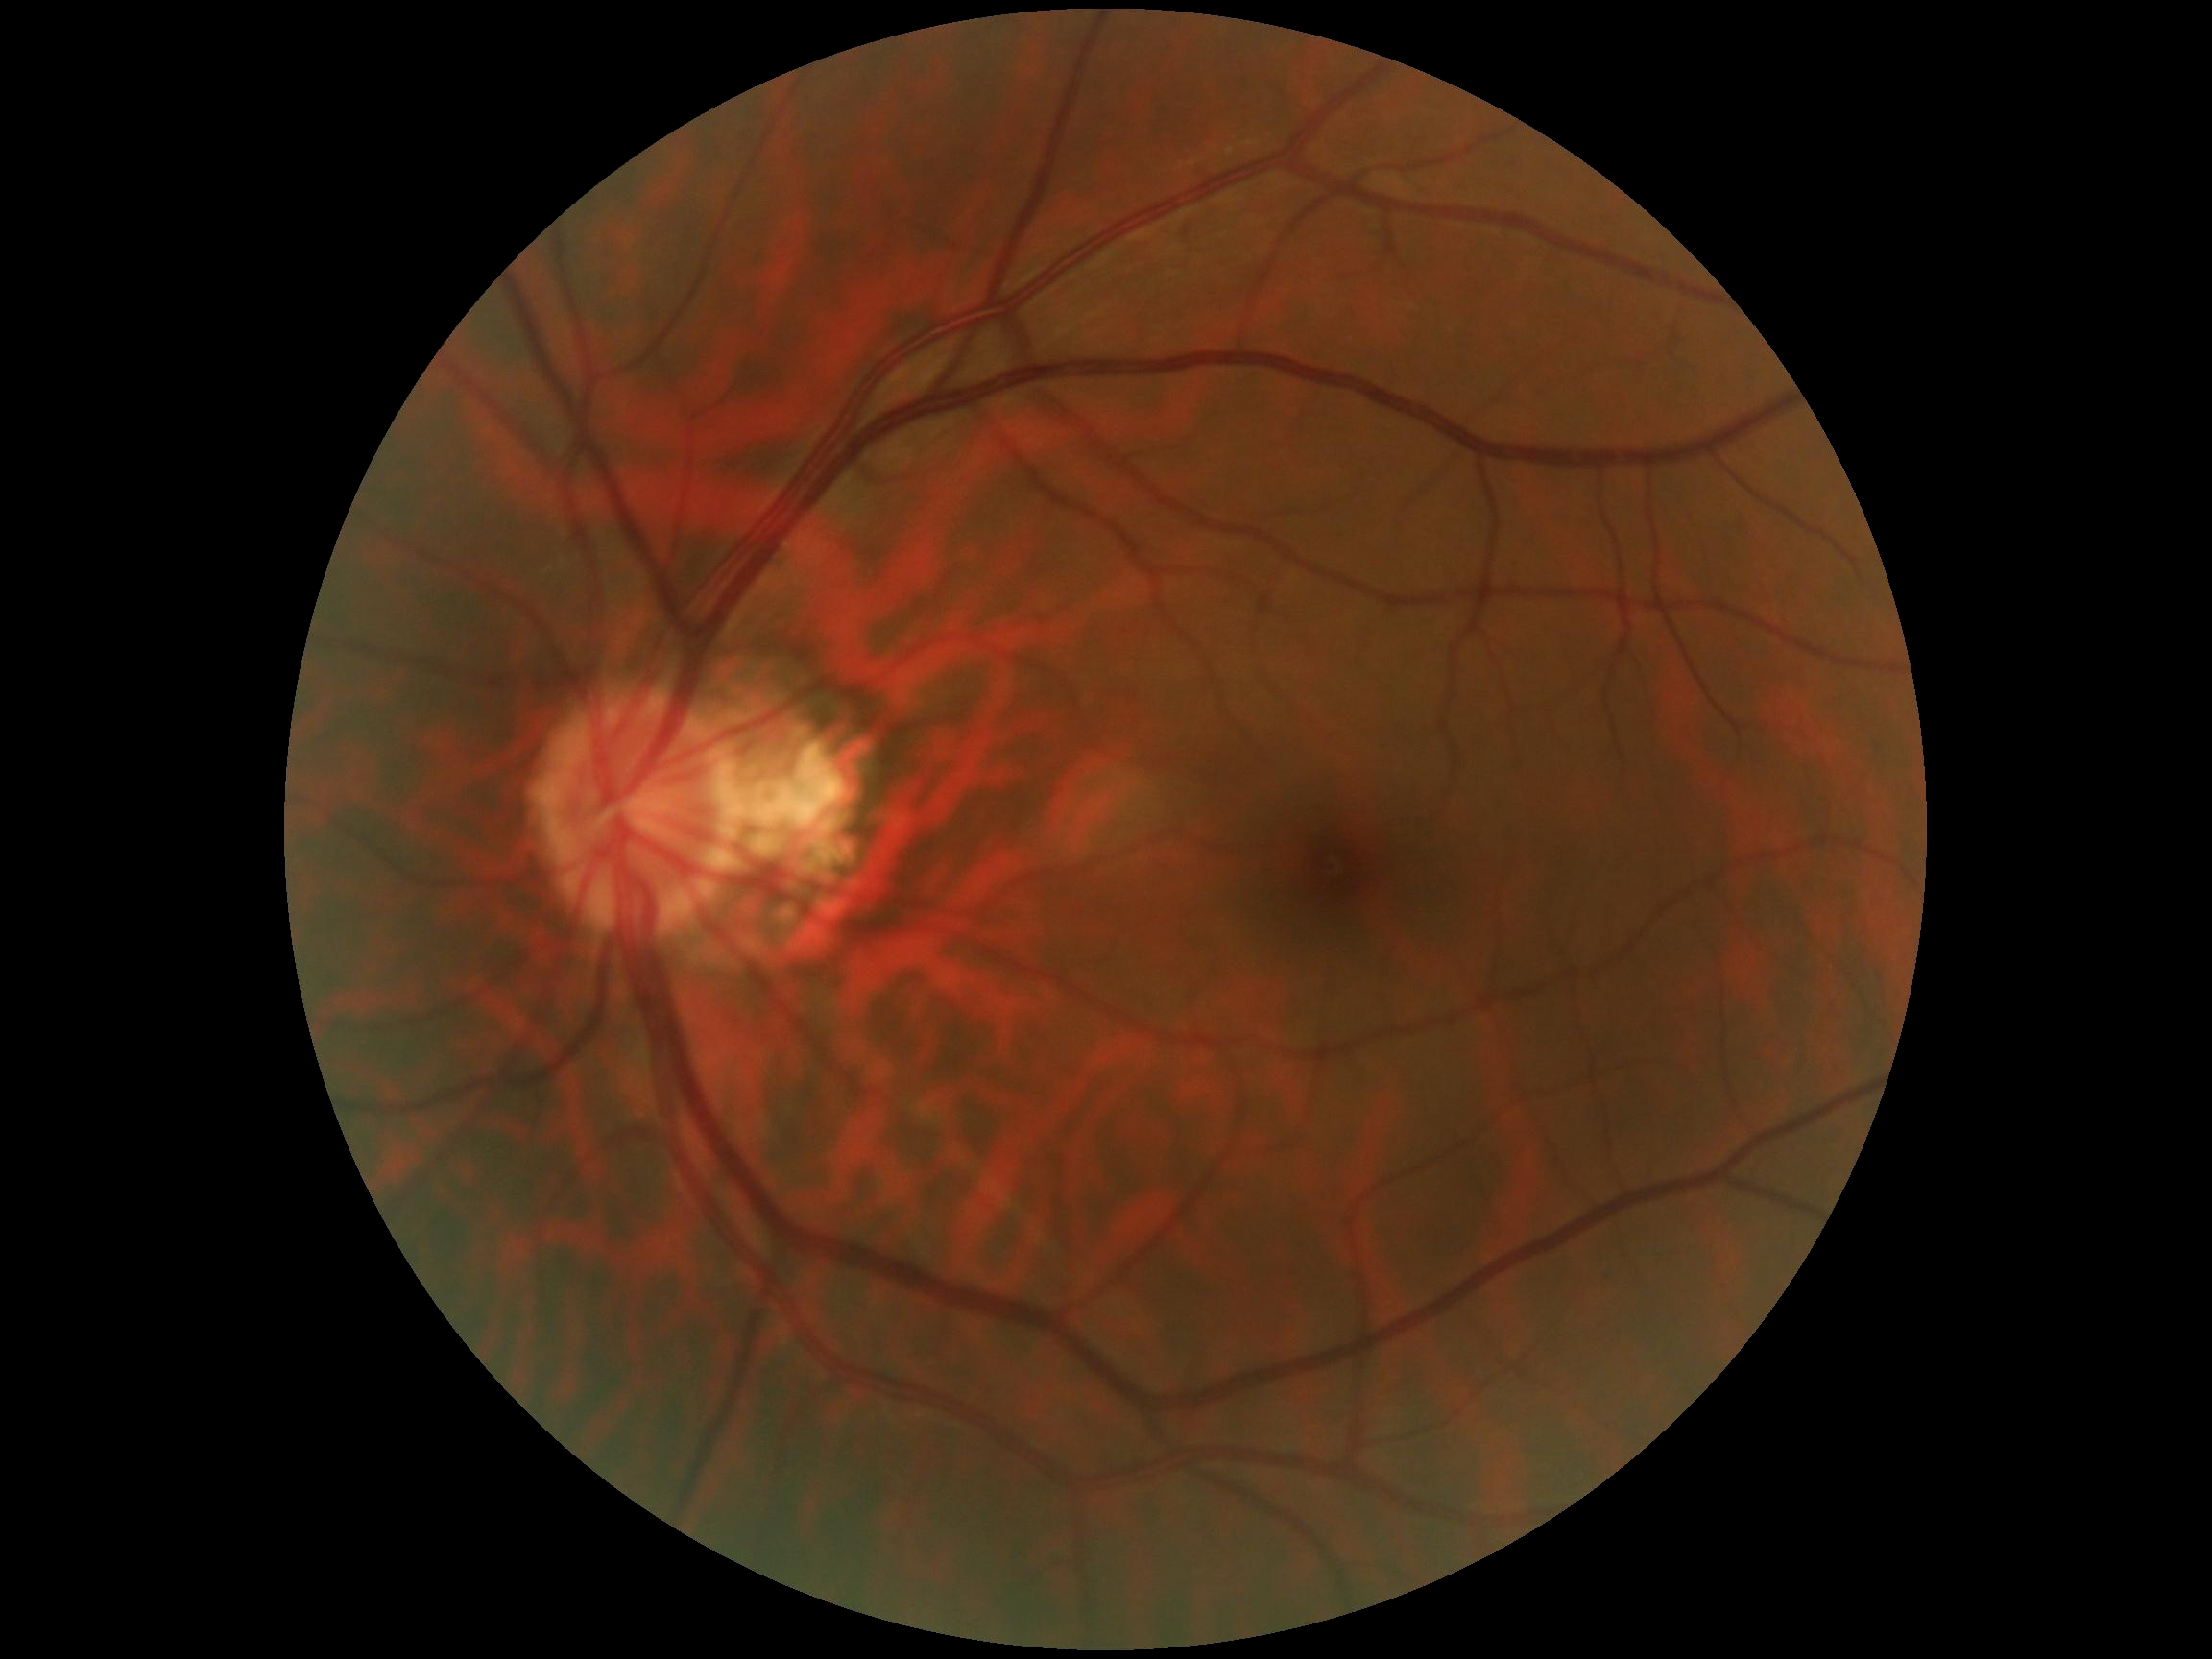 DR severity@grade 0.